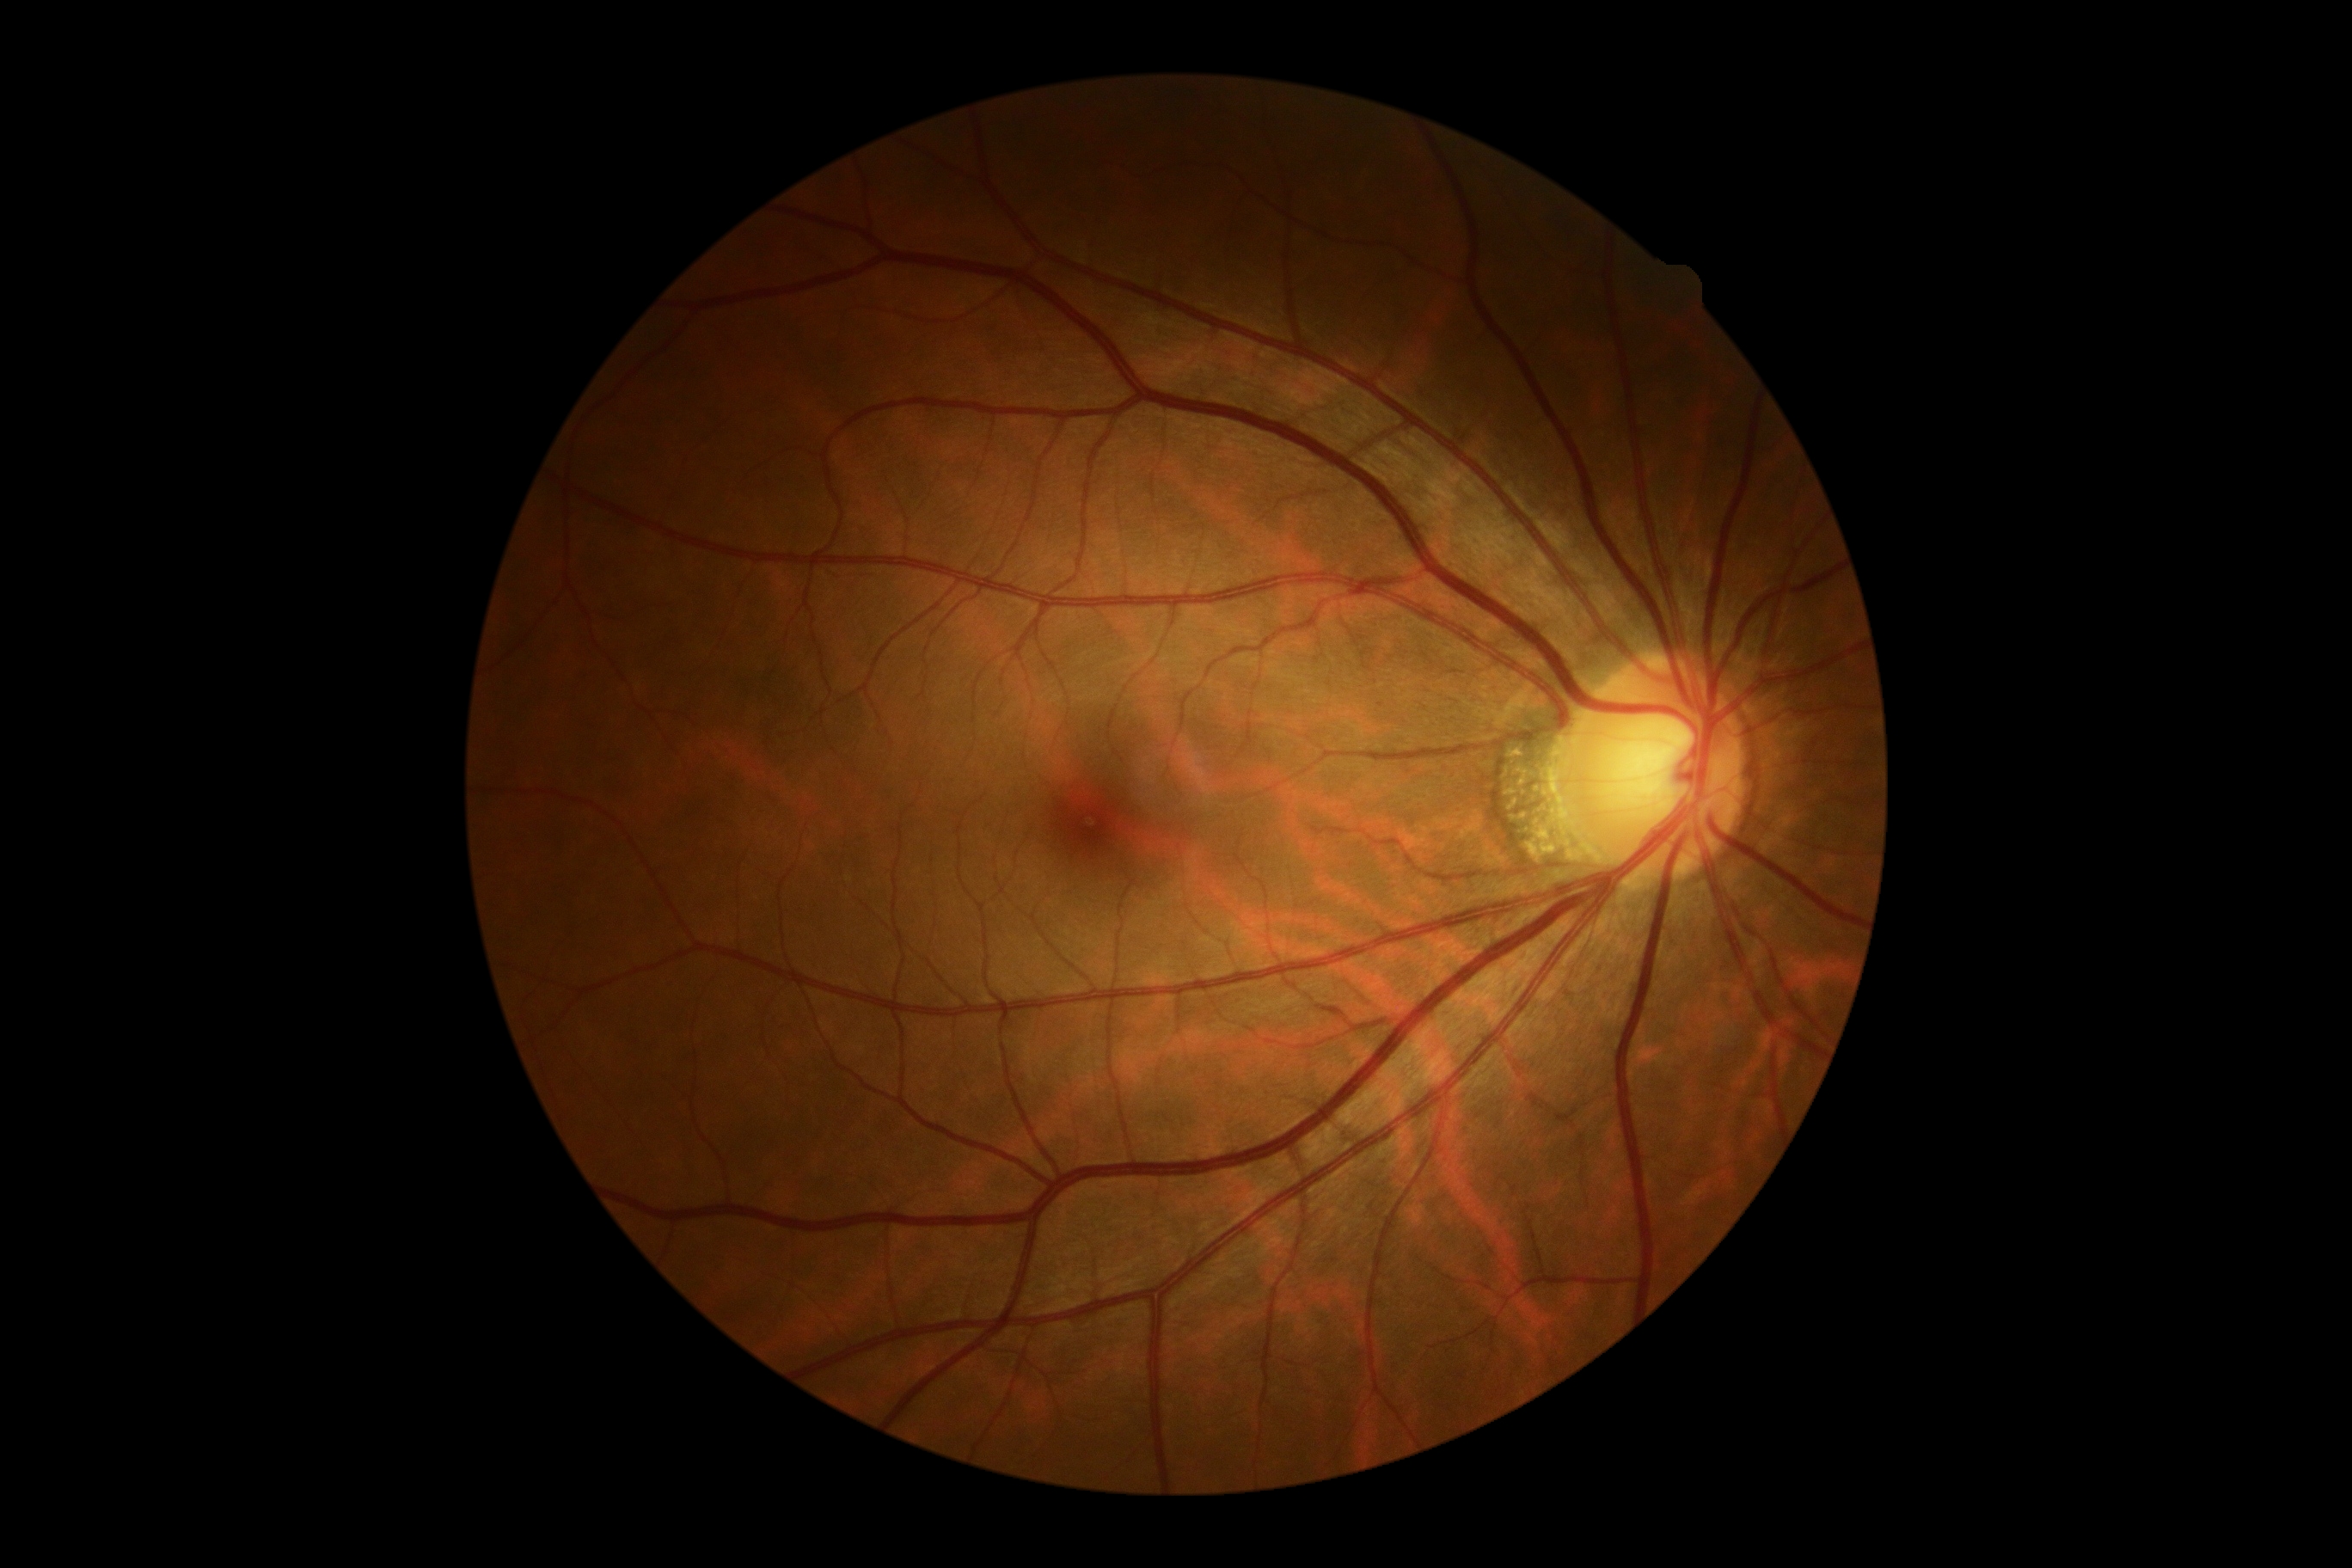 DR grade: no apparent diabetic retinopathy (0).